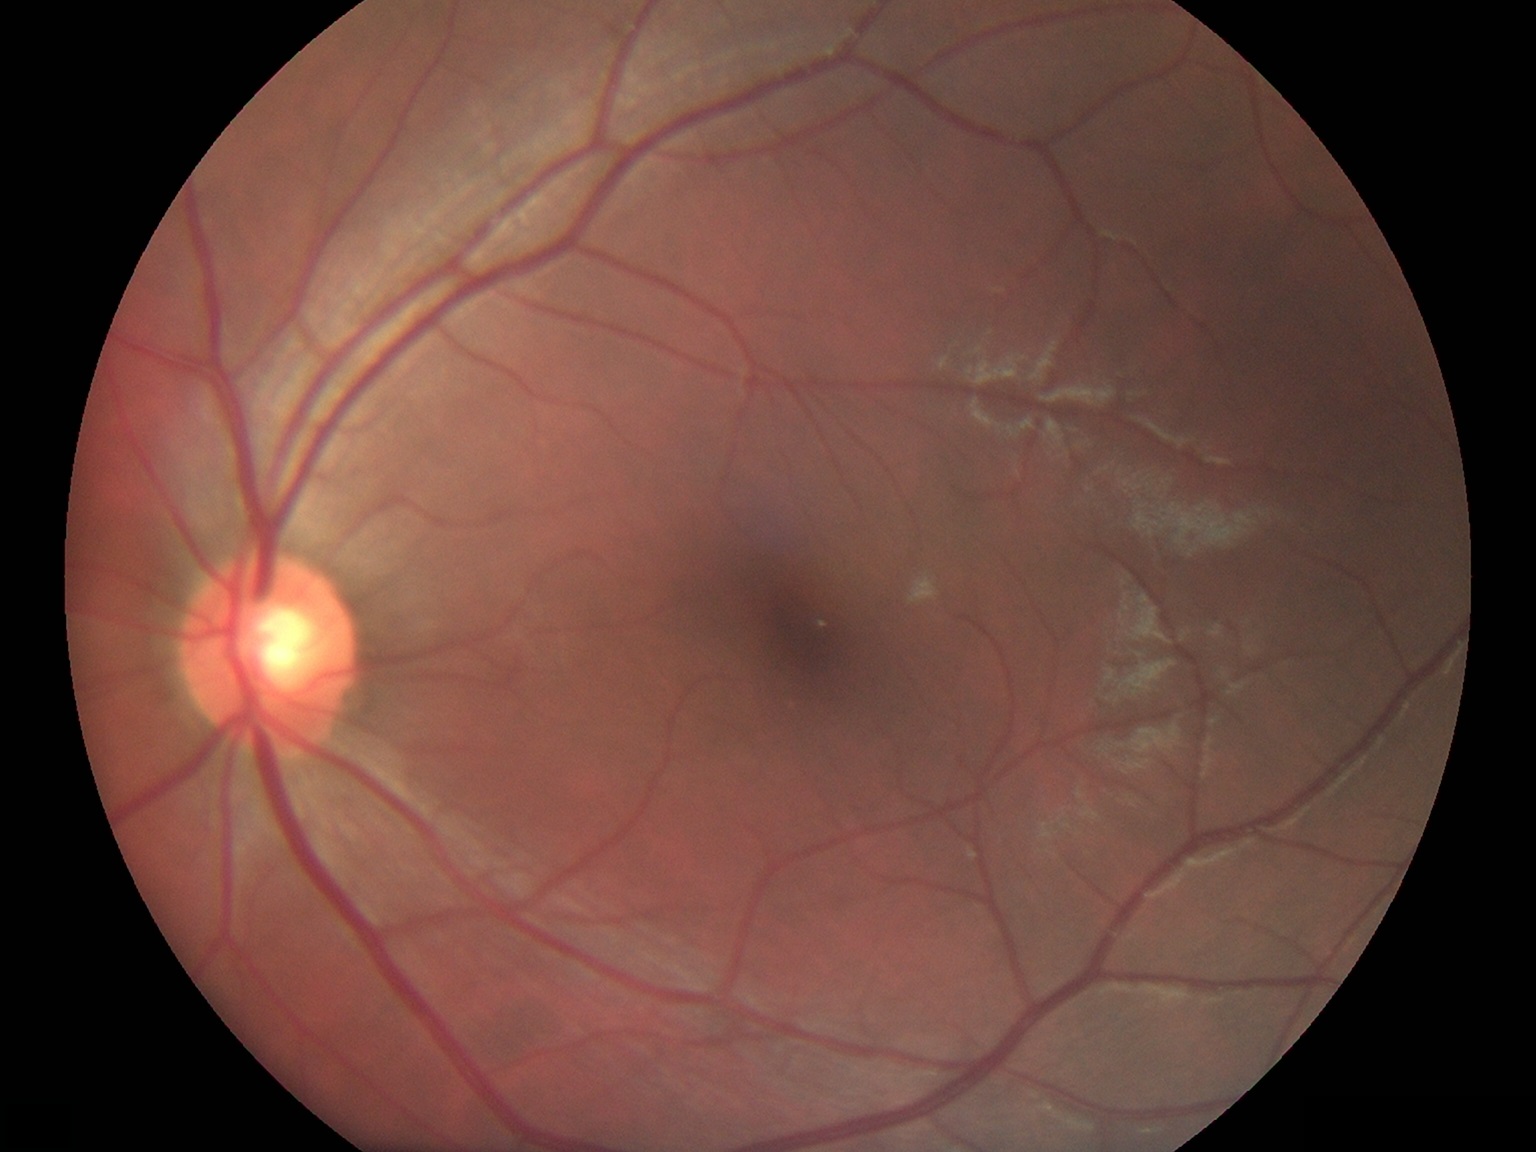

DR stage: no apparent diabetic retinopathy (grade 0) | DR impression: no apparent DR.